Remidio Fundus on Phone (FOP) camera — 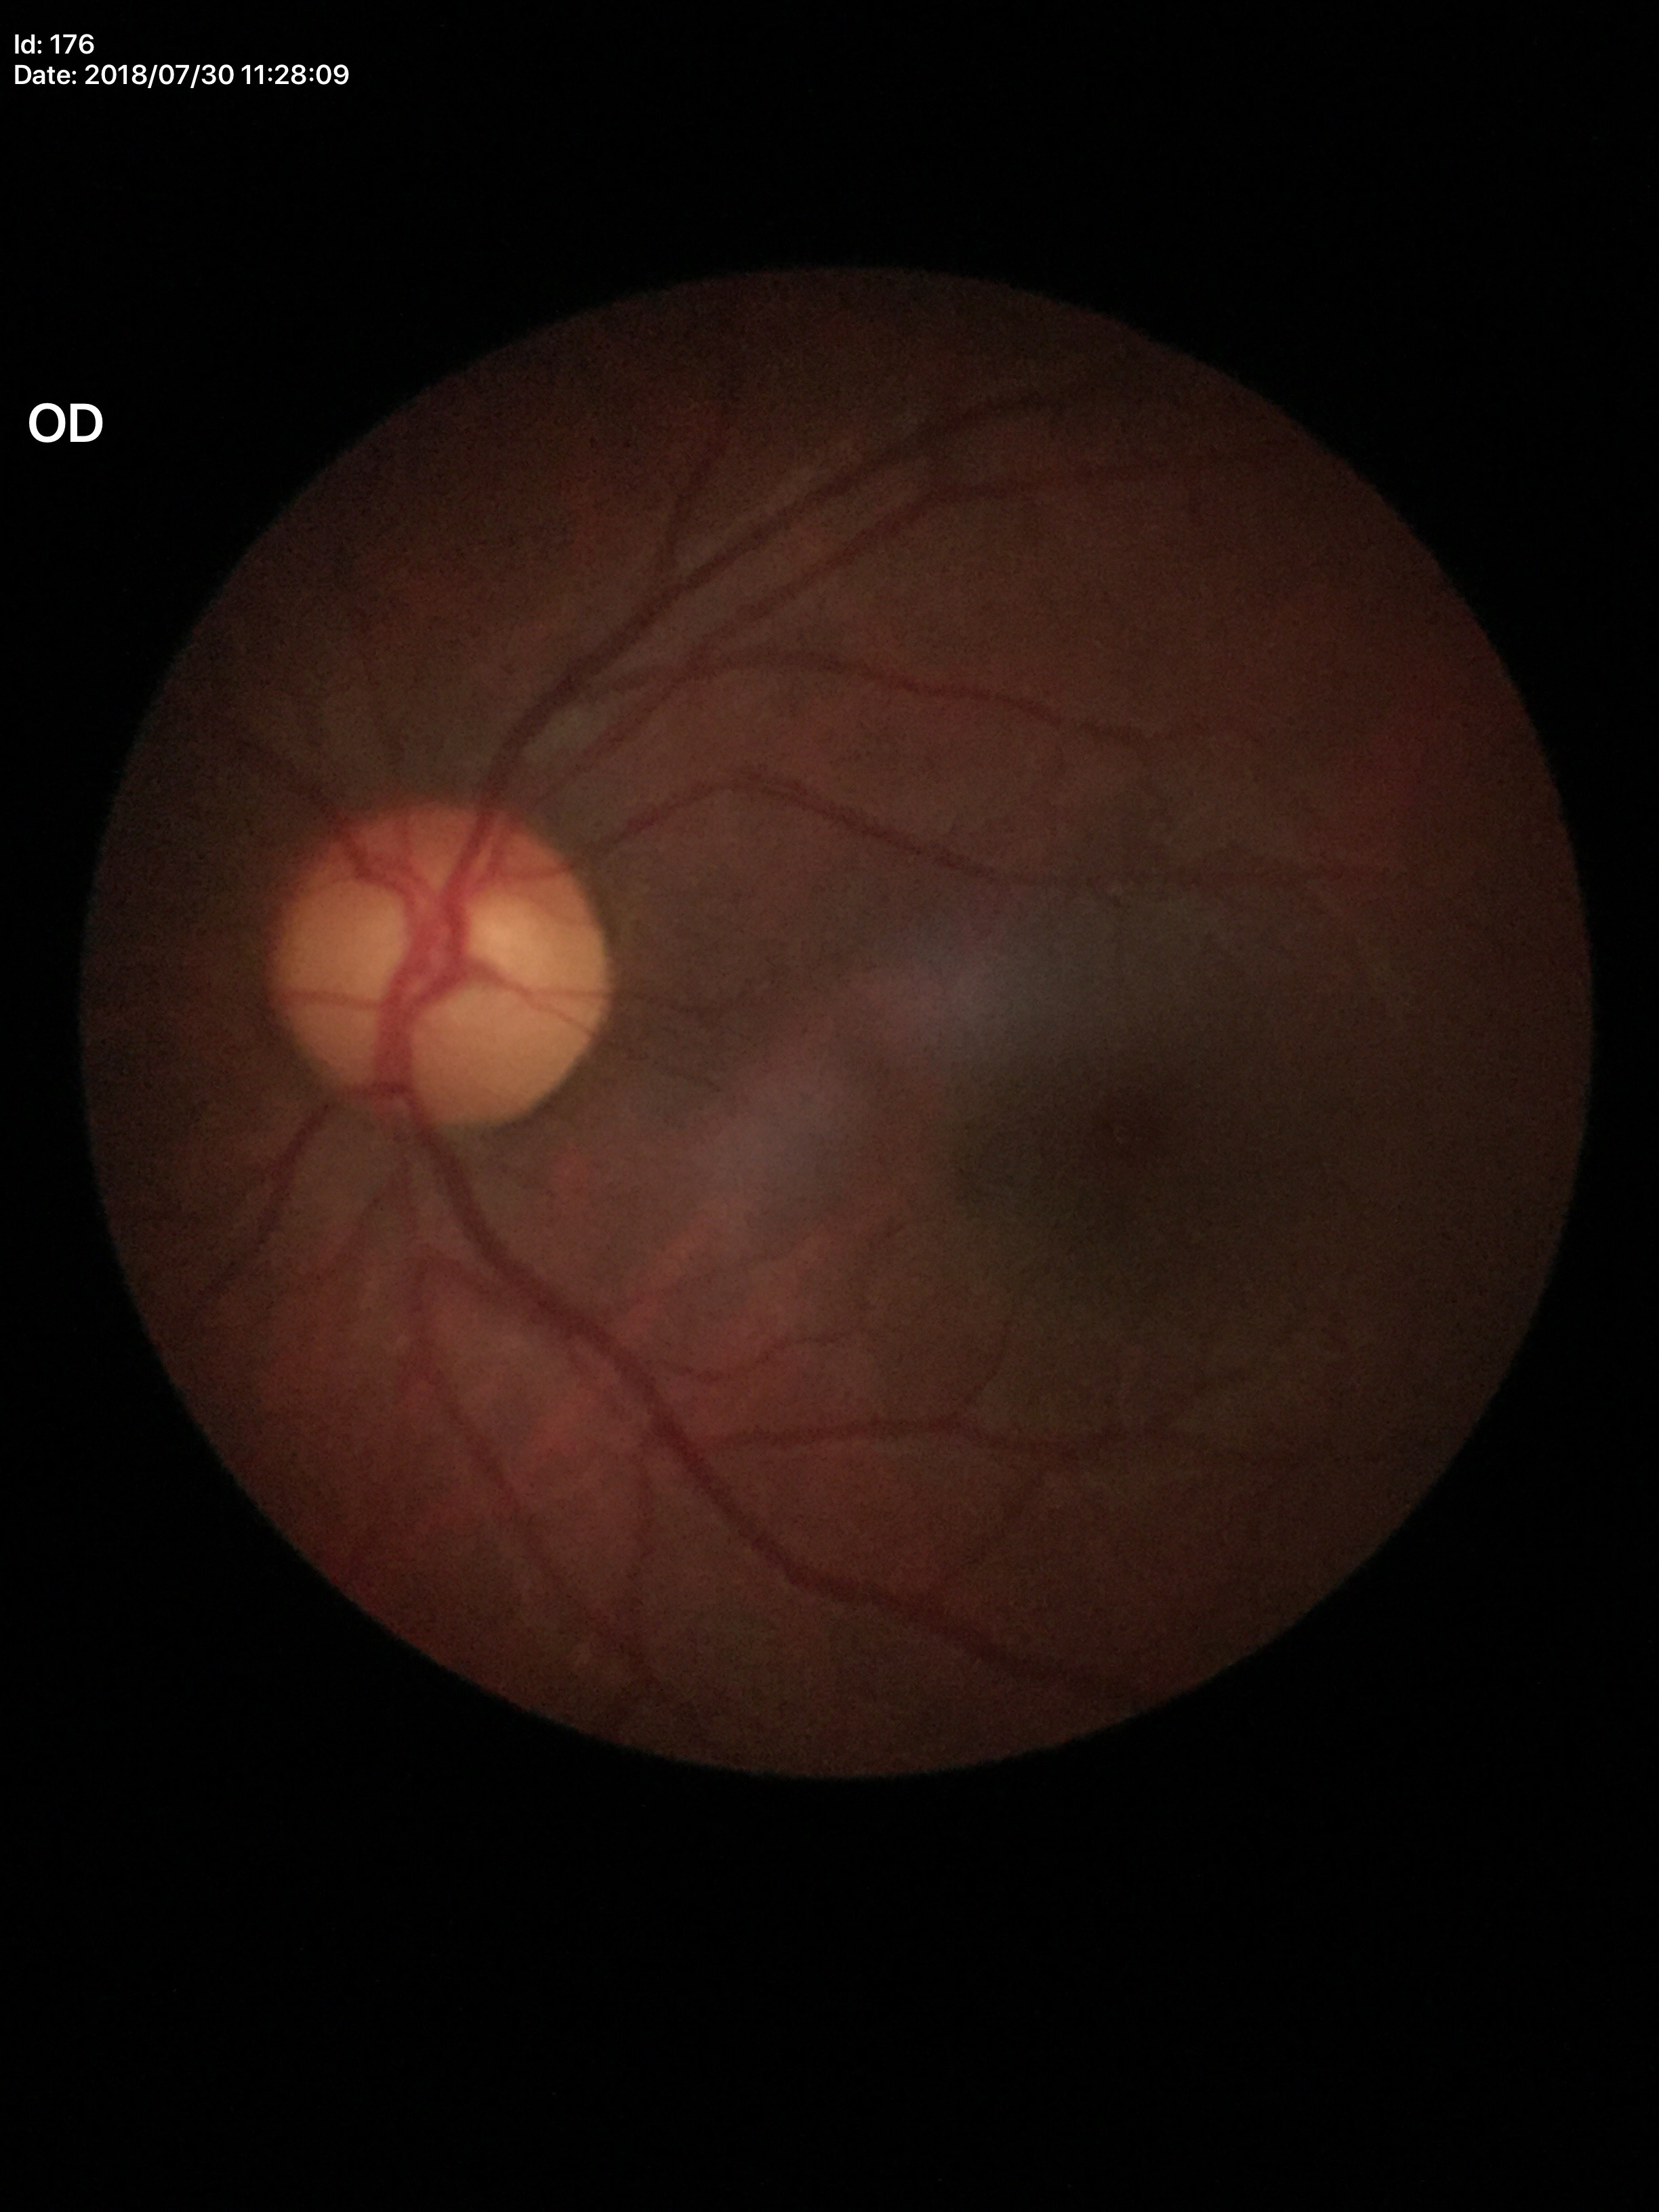 Glaucoma screening=no suspicious findings
vertical C/D ratio=0.51